2048 by 1536 pixels
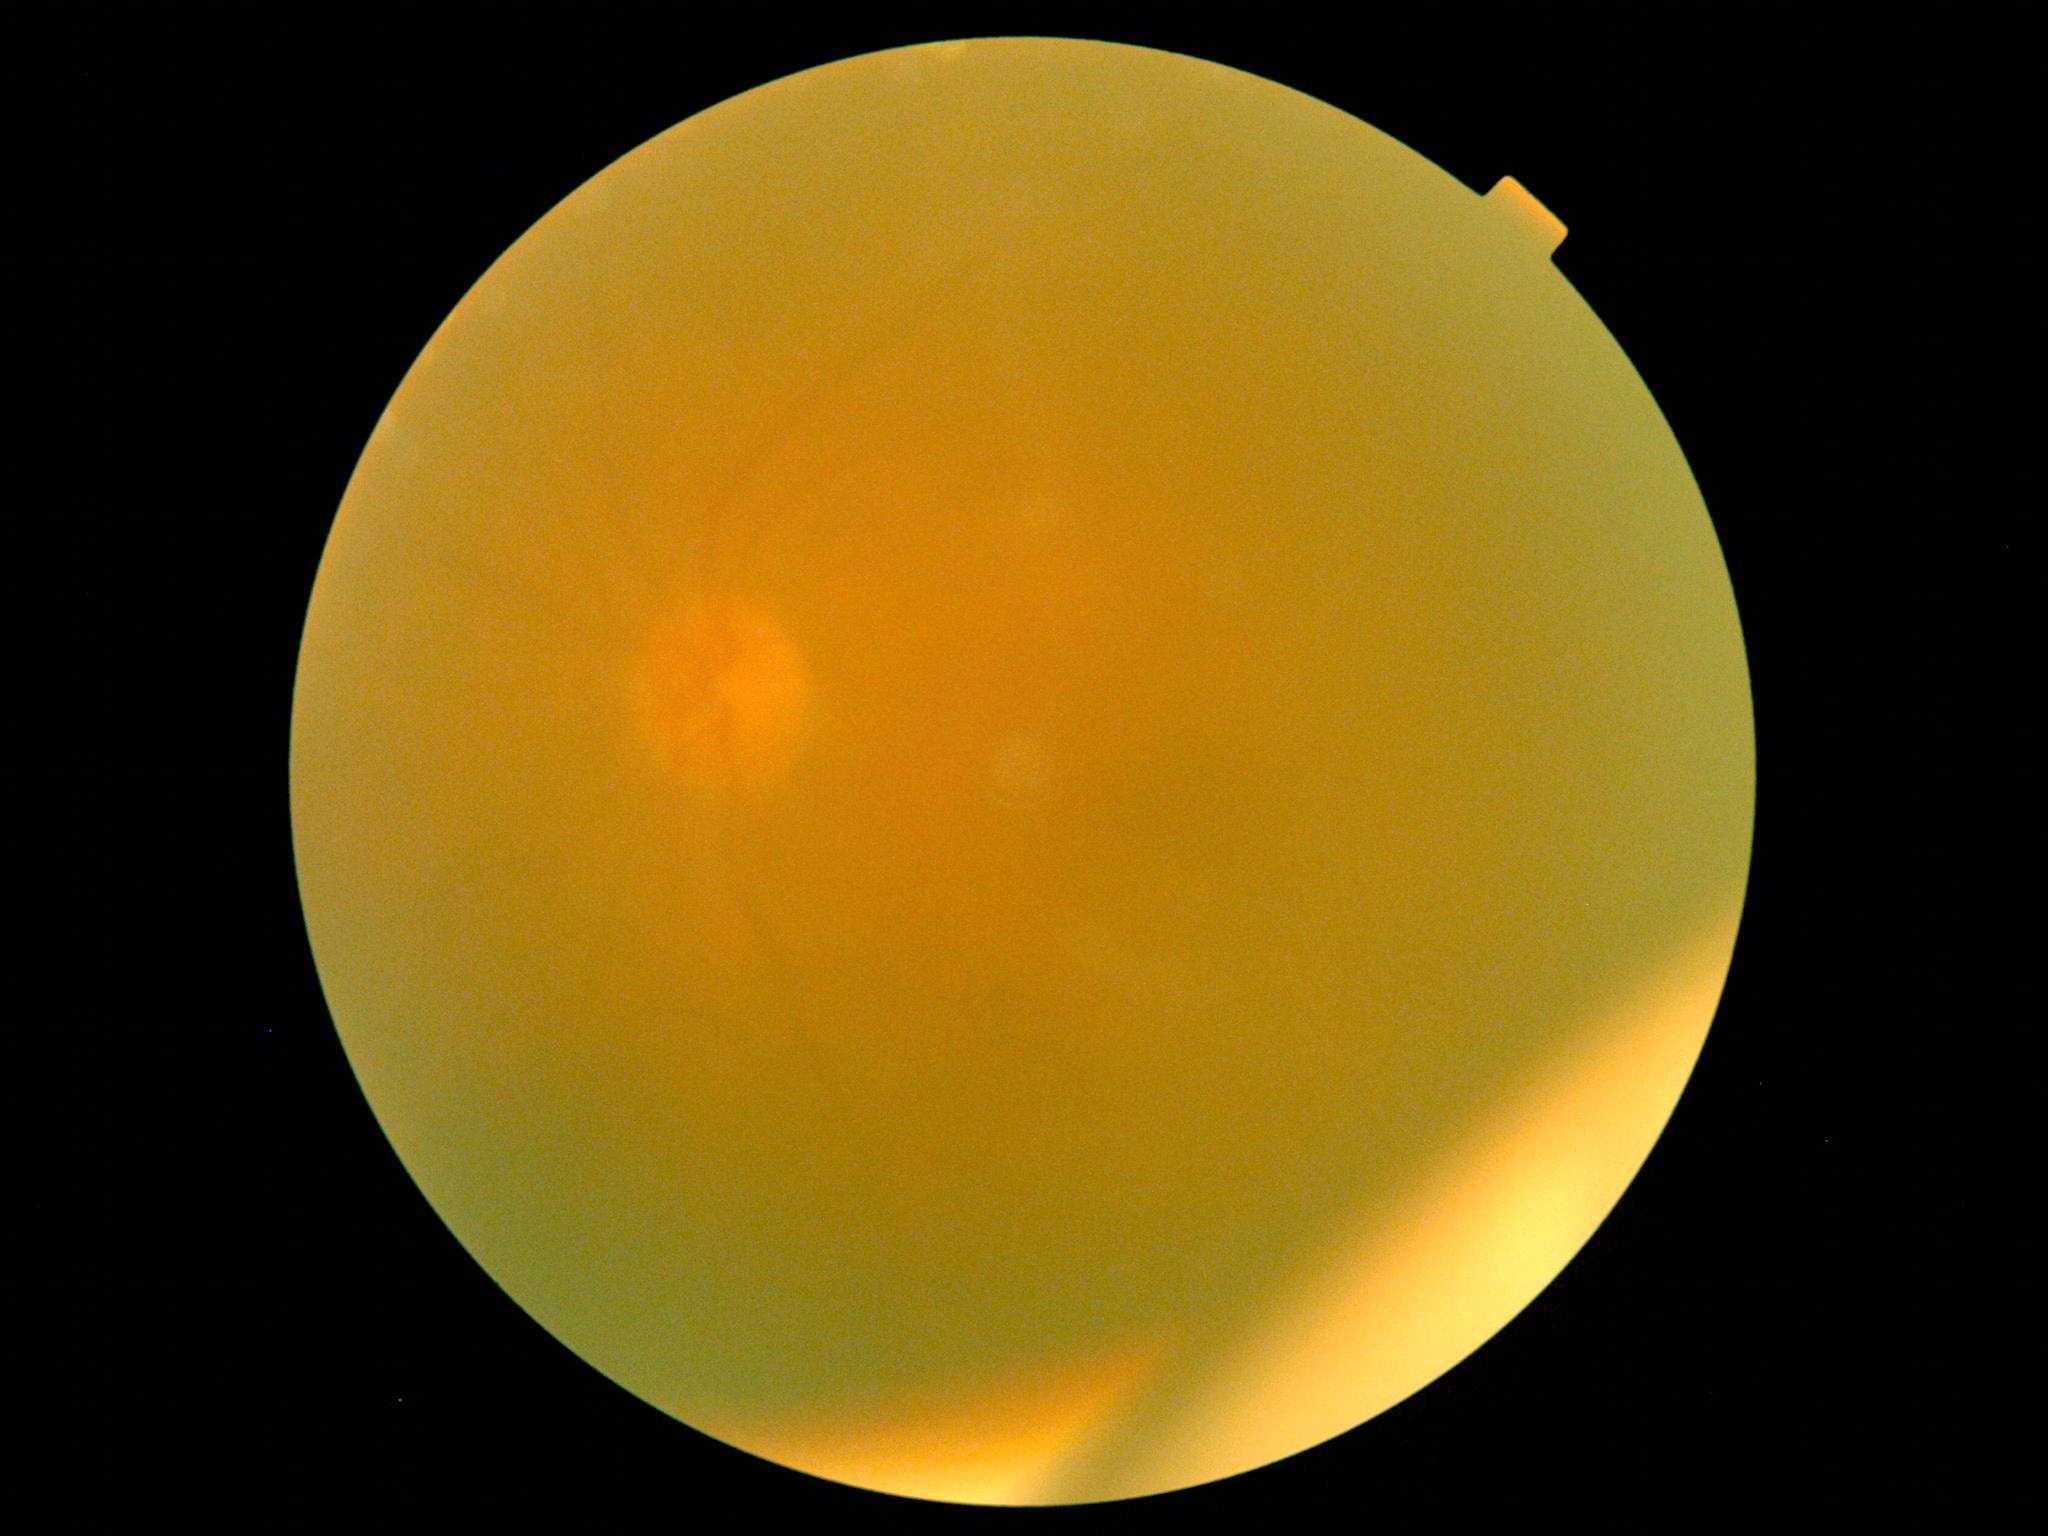 DR grade: ungradable due to poor image quality.